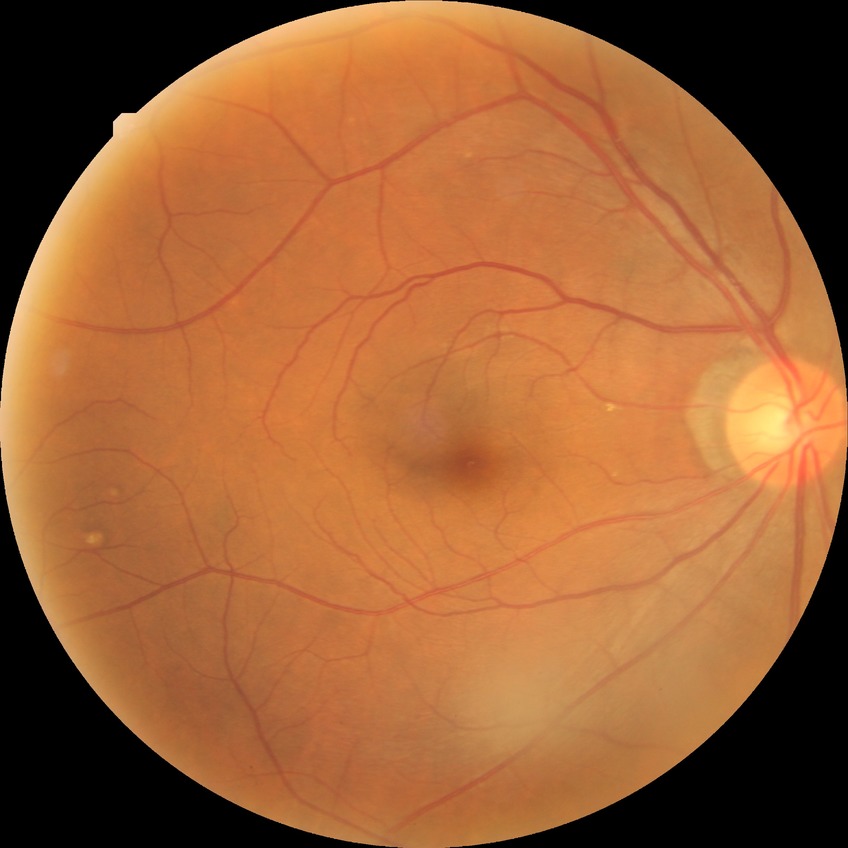 Diabetic retinopathy (DR): no diabetic retinopathy (NDR).